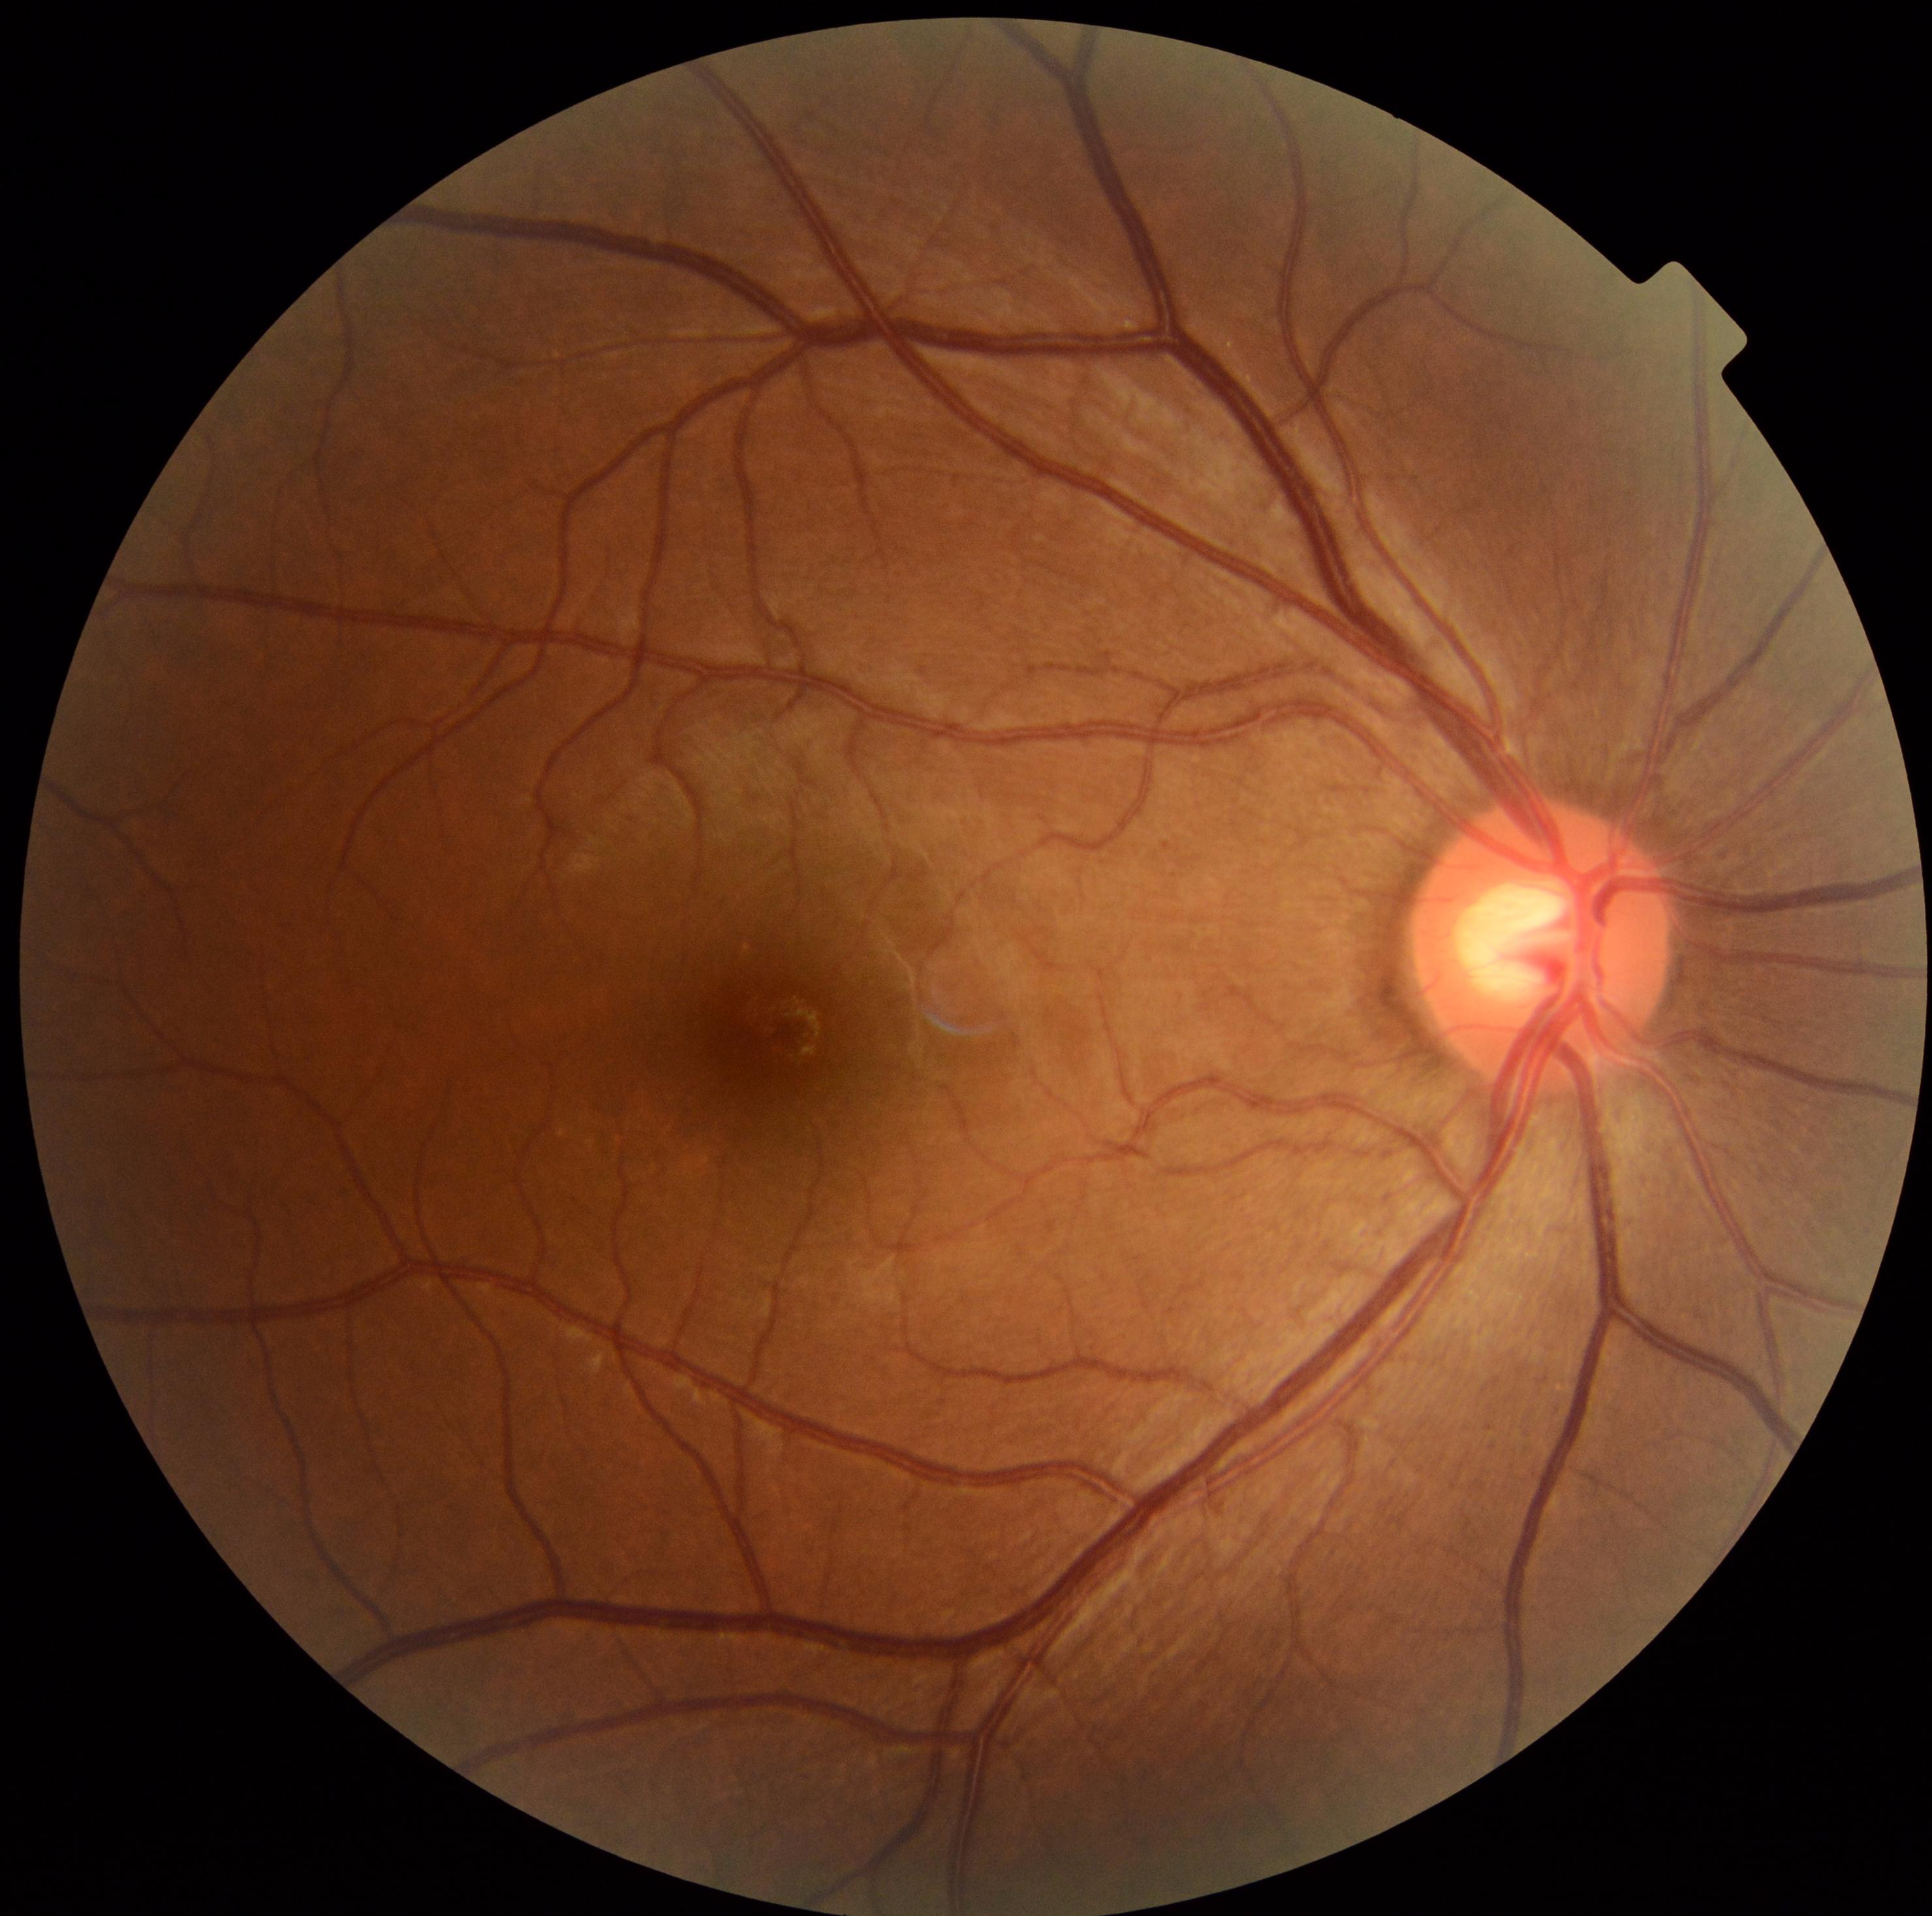
Diabetic retinopathy (DR) is 0.